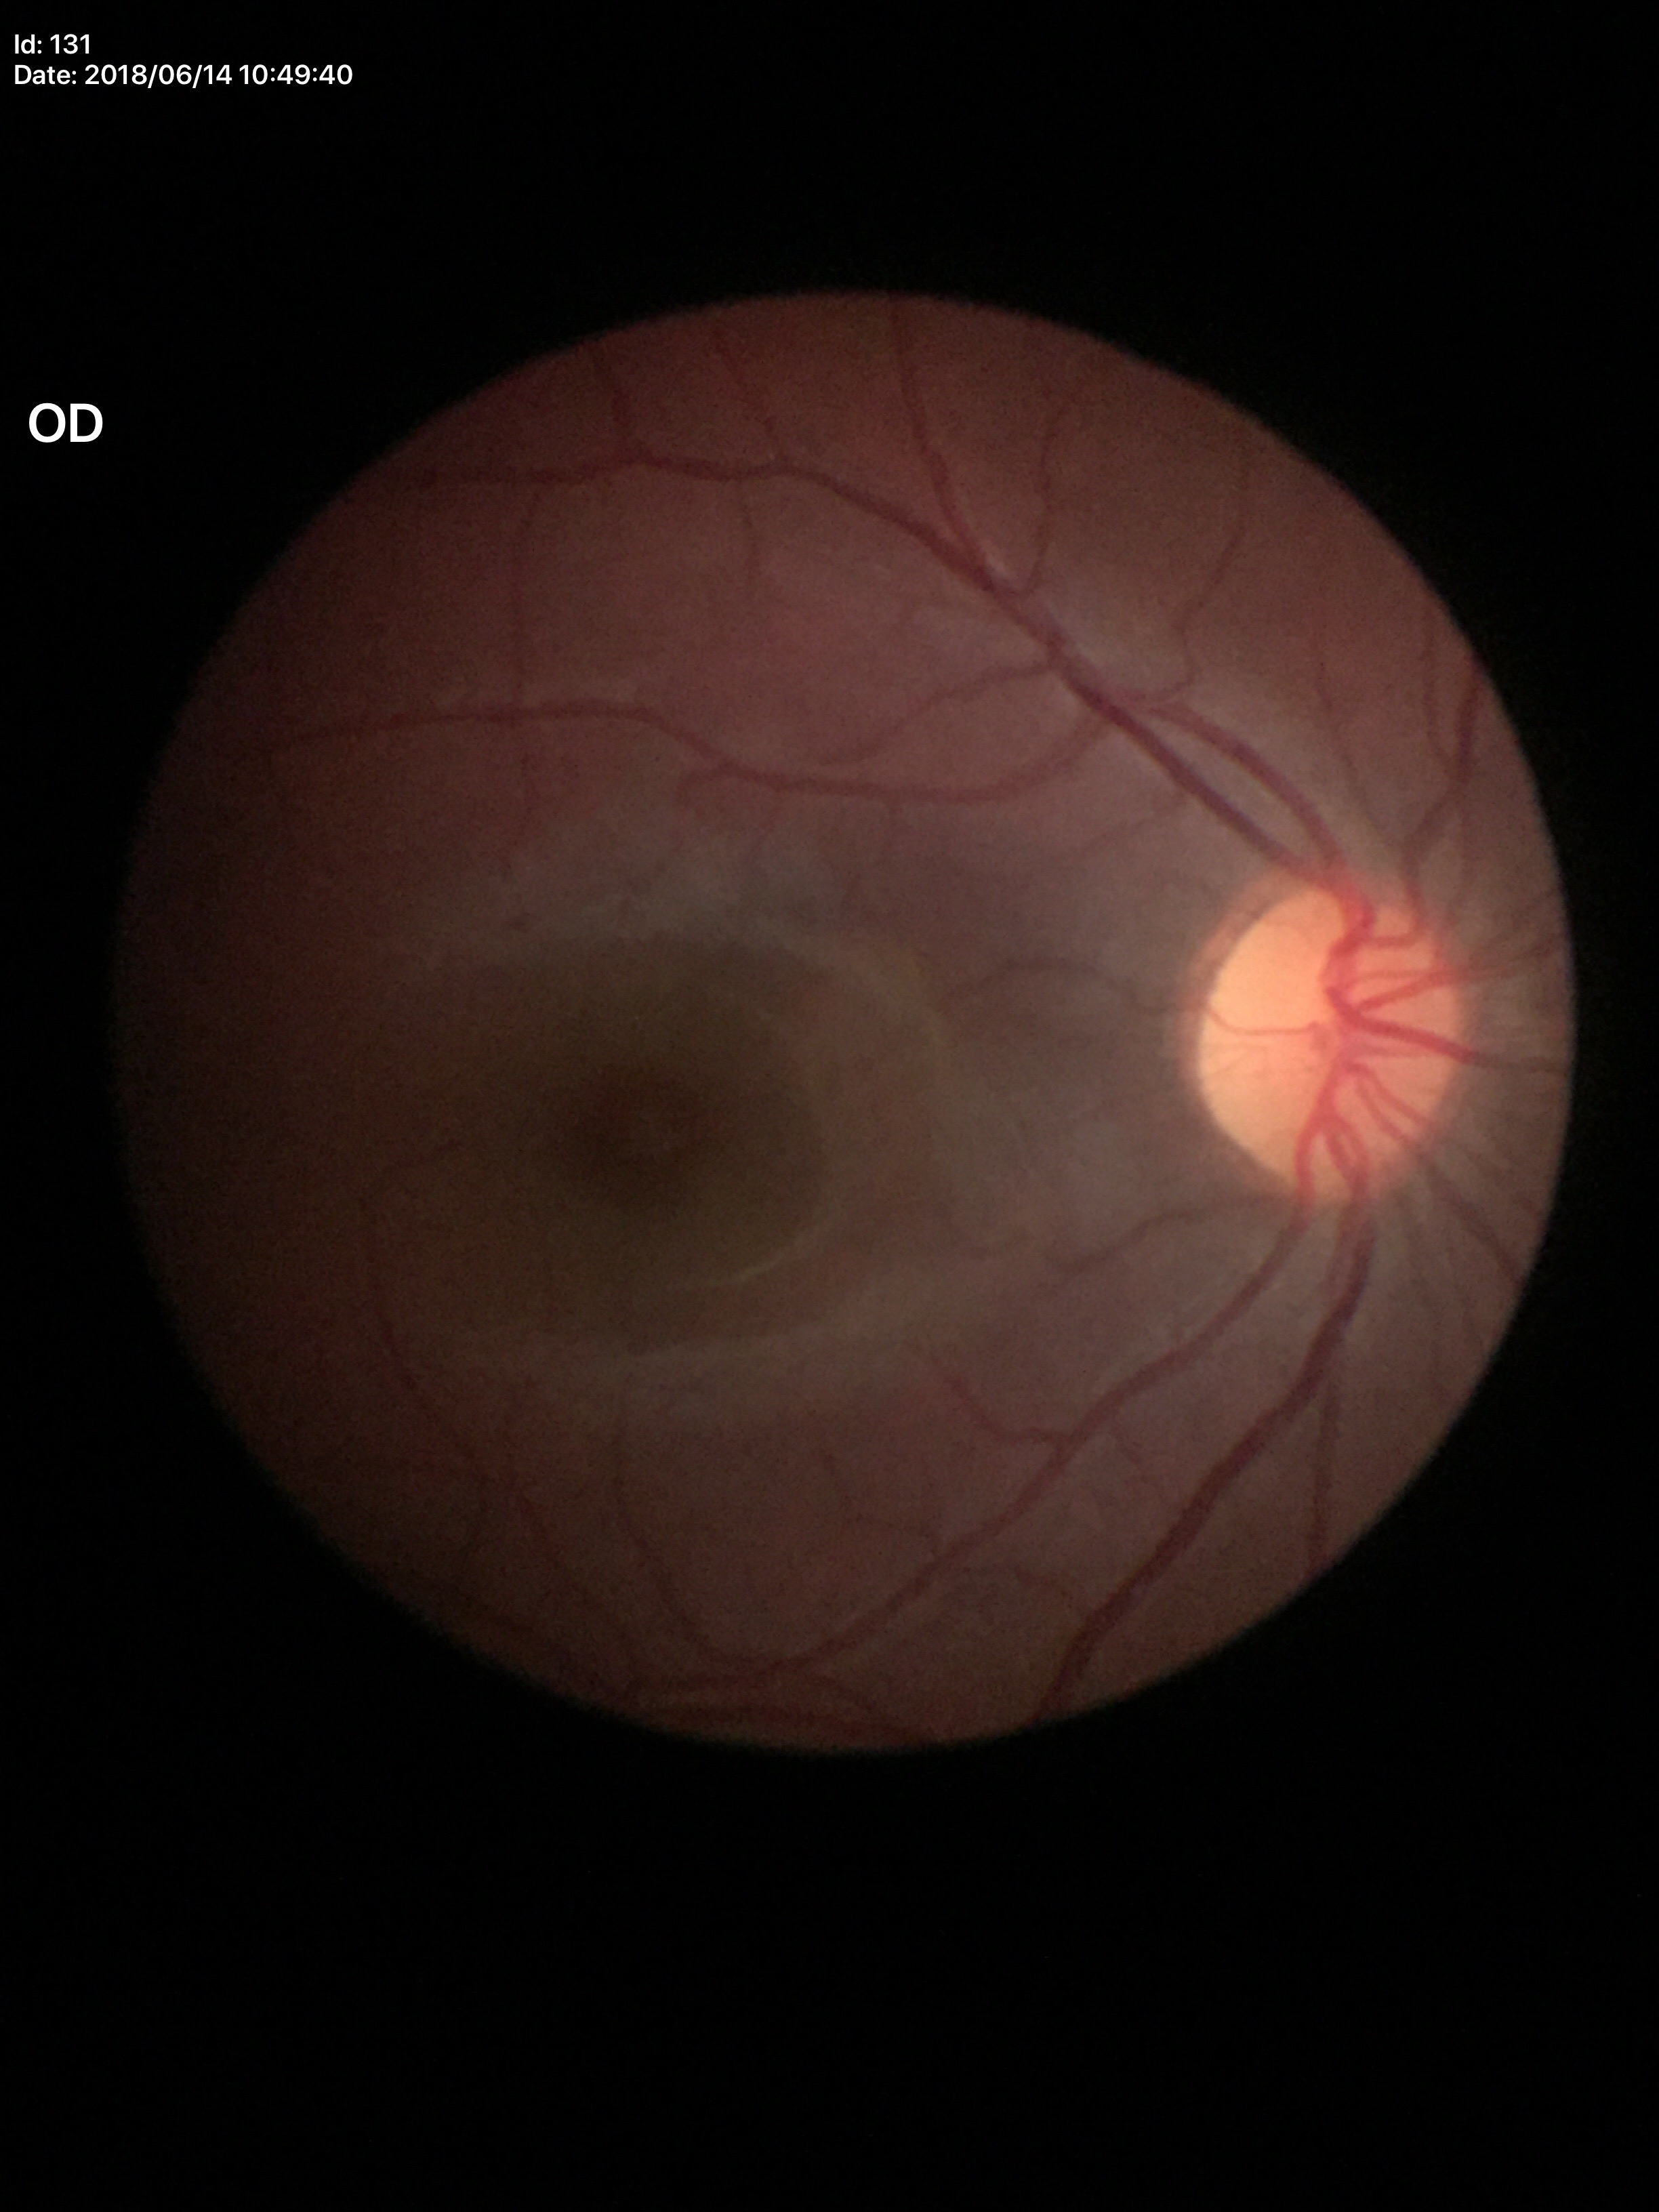 Glaucoma evaluation: no suspicious findings. Vertical CDR (VCDR): 0.39.